No pharmacologic dilation. Color fundus image. 848 by 848 pixels. 45-degree field of view. Camera: NIDEK AFC-230: 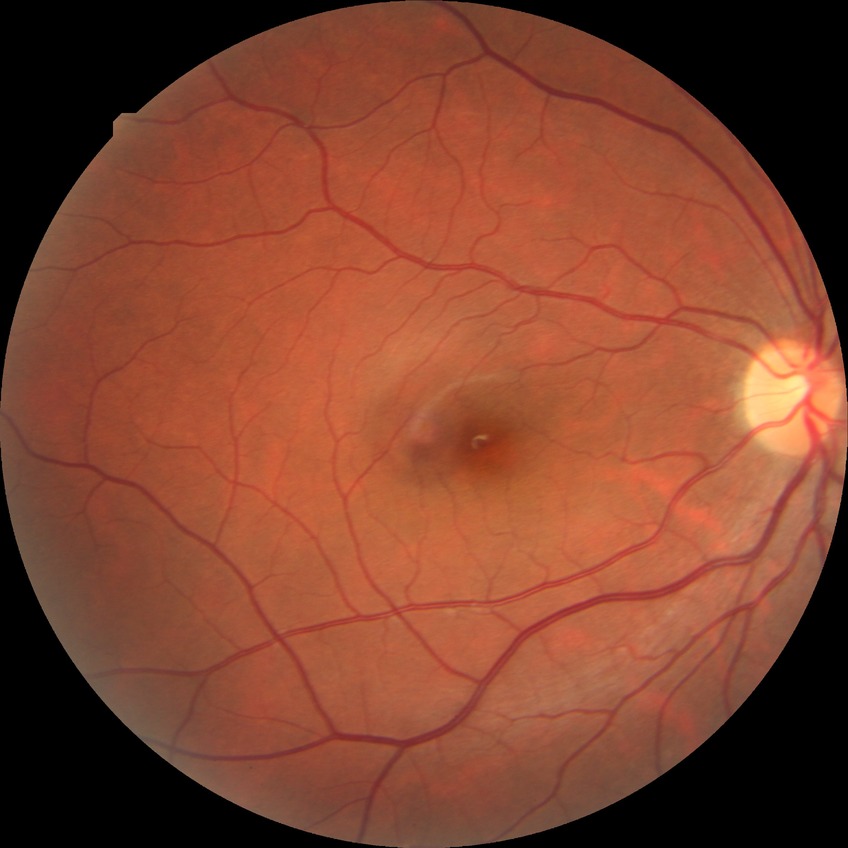

Annotations:
- retinopathy grade: no diabetic retinopathy